Color fundus photograph from a handheld portable camera:
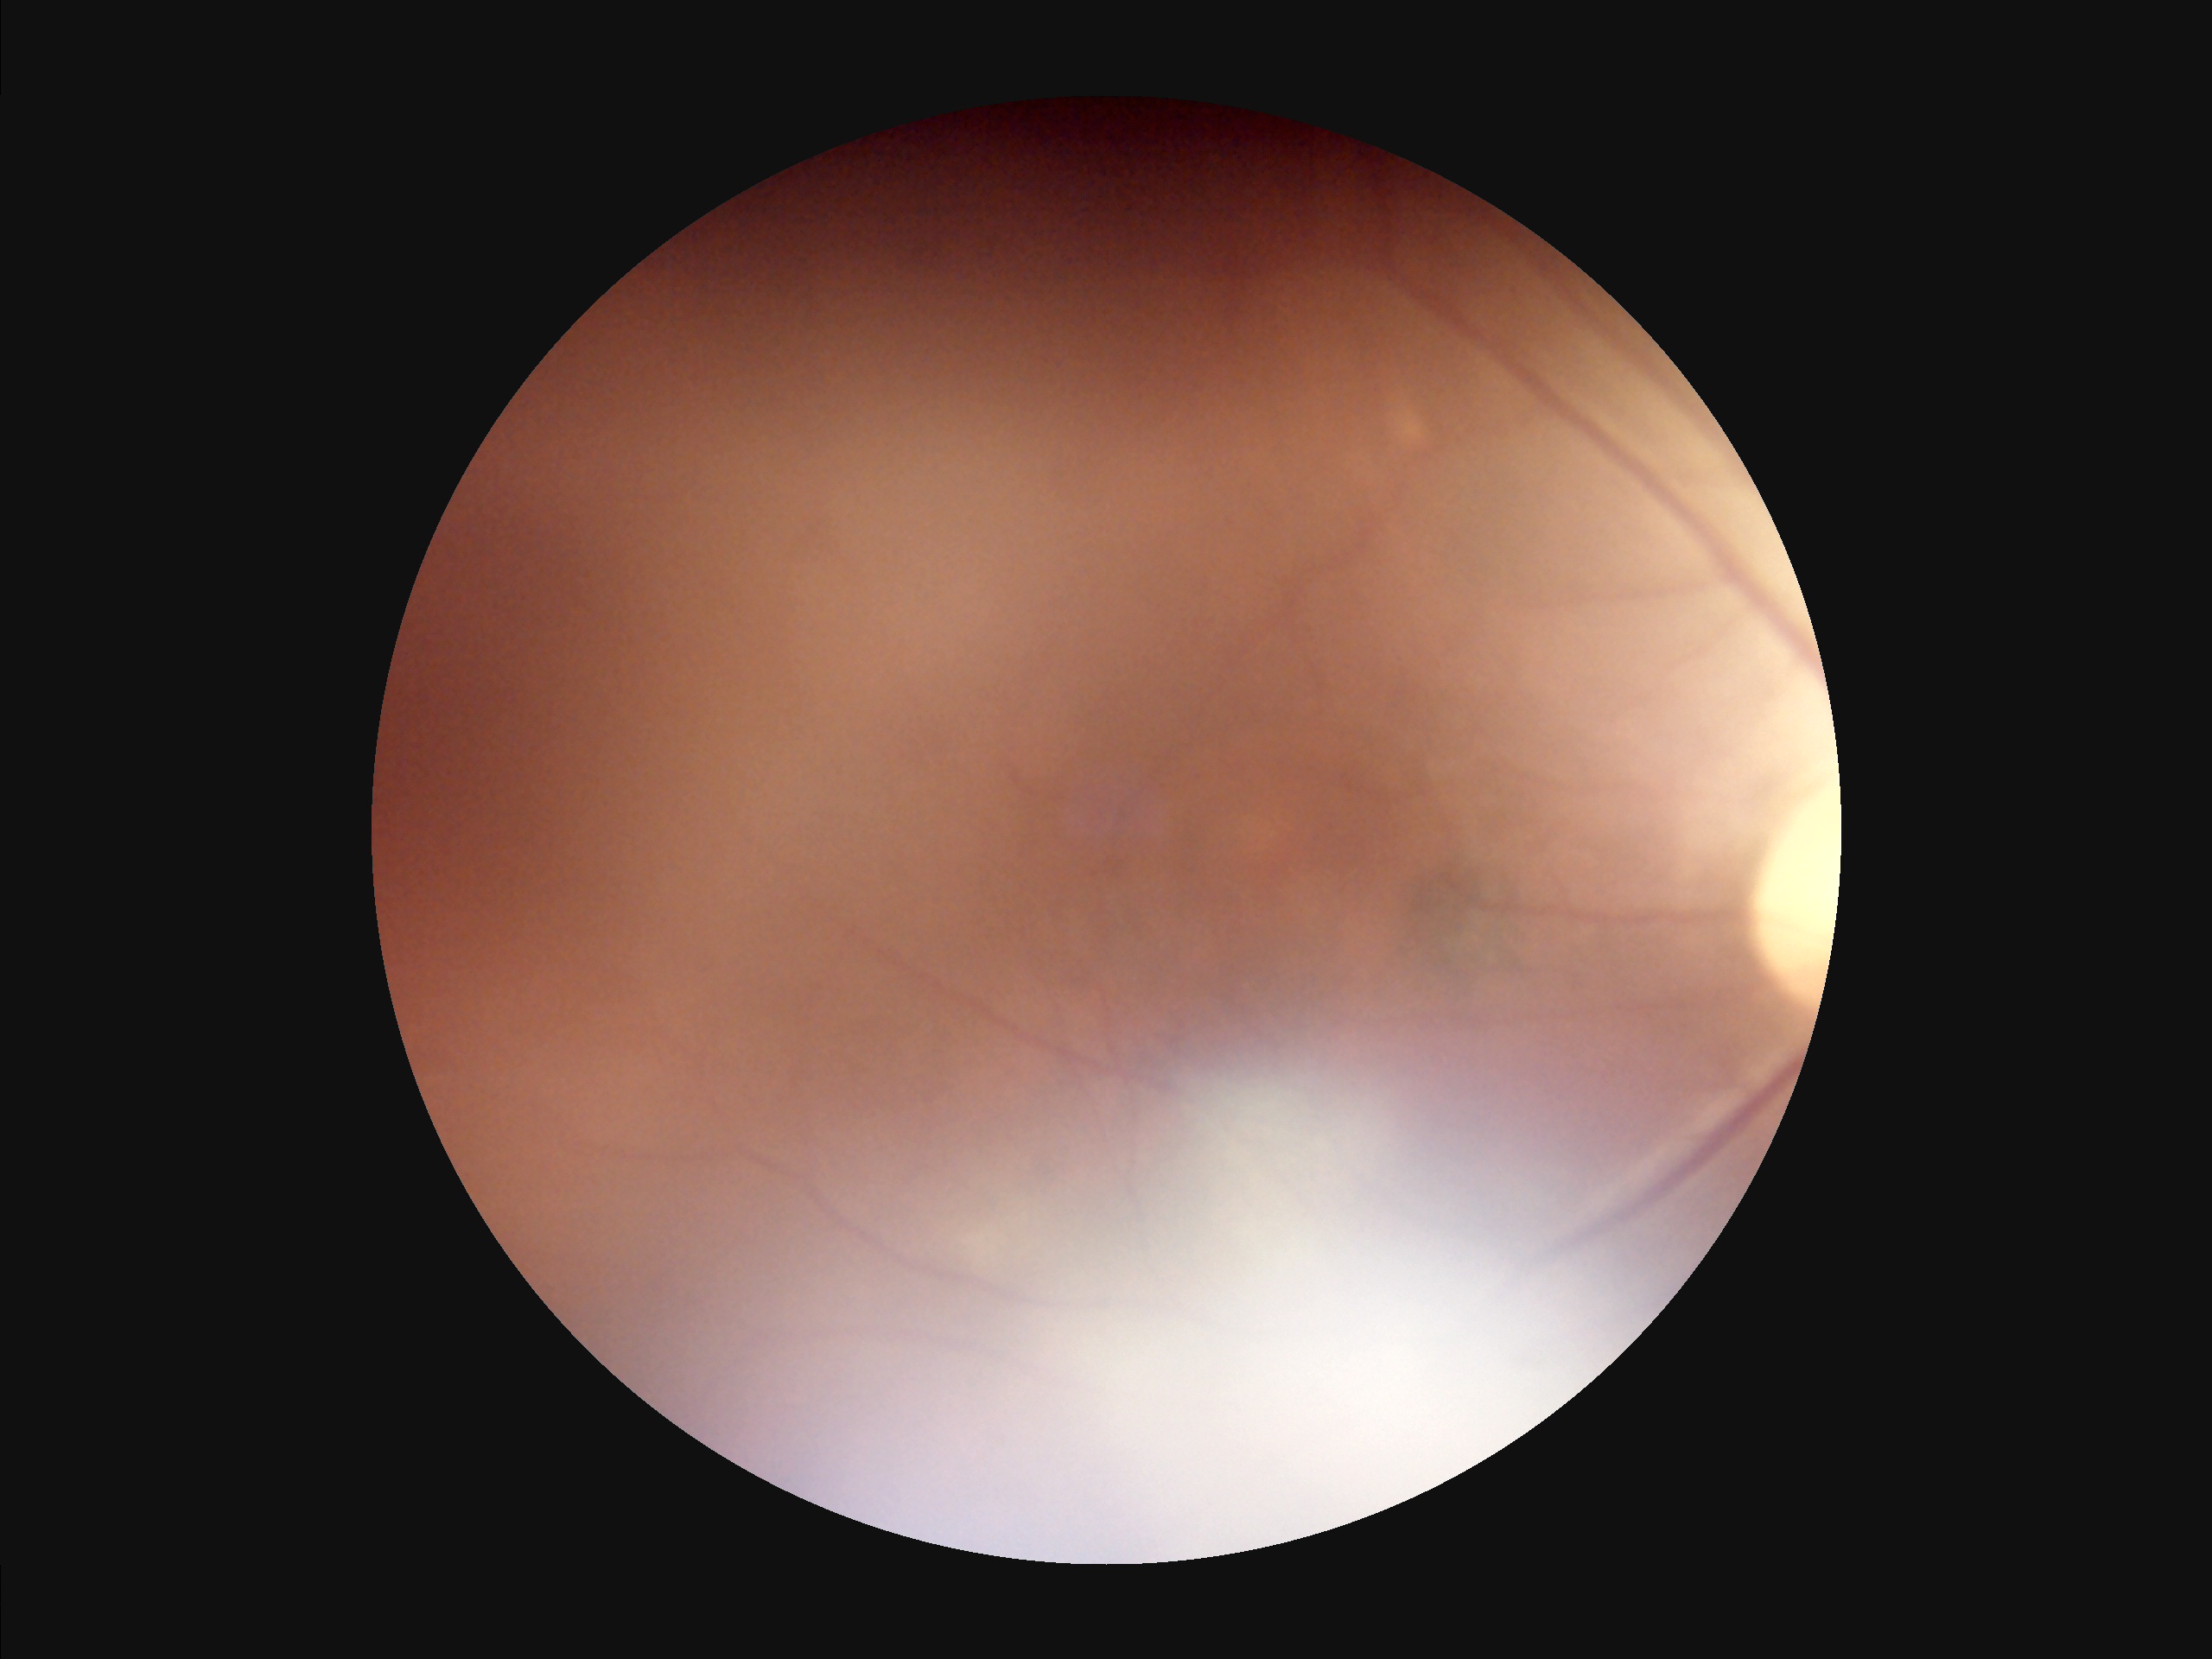   contrast: narrow intensity range, structures hard to distinguish
  illumination: uneven illumination or color cast
  overall_quality: inadequate for clinical interpretation
  clarity: reduced sharpness with visible blur